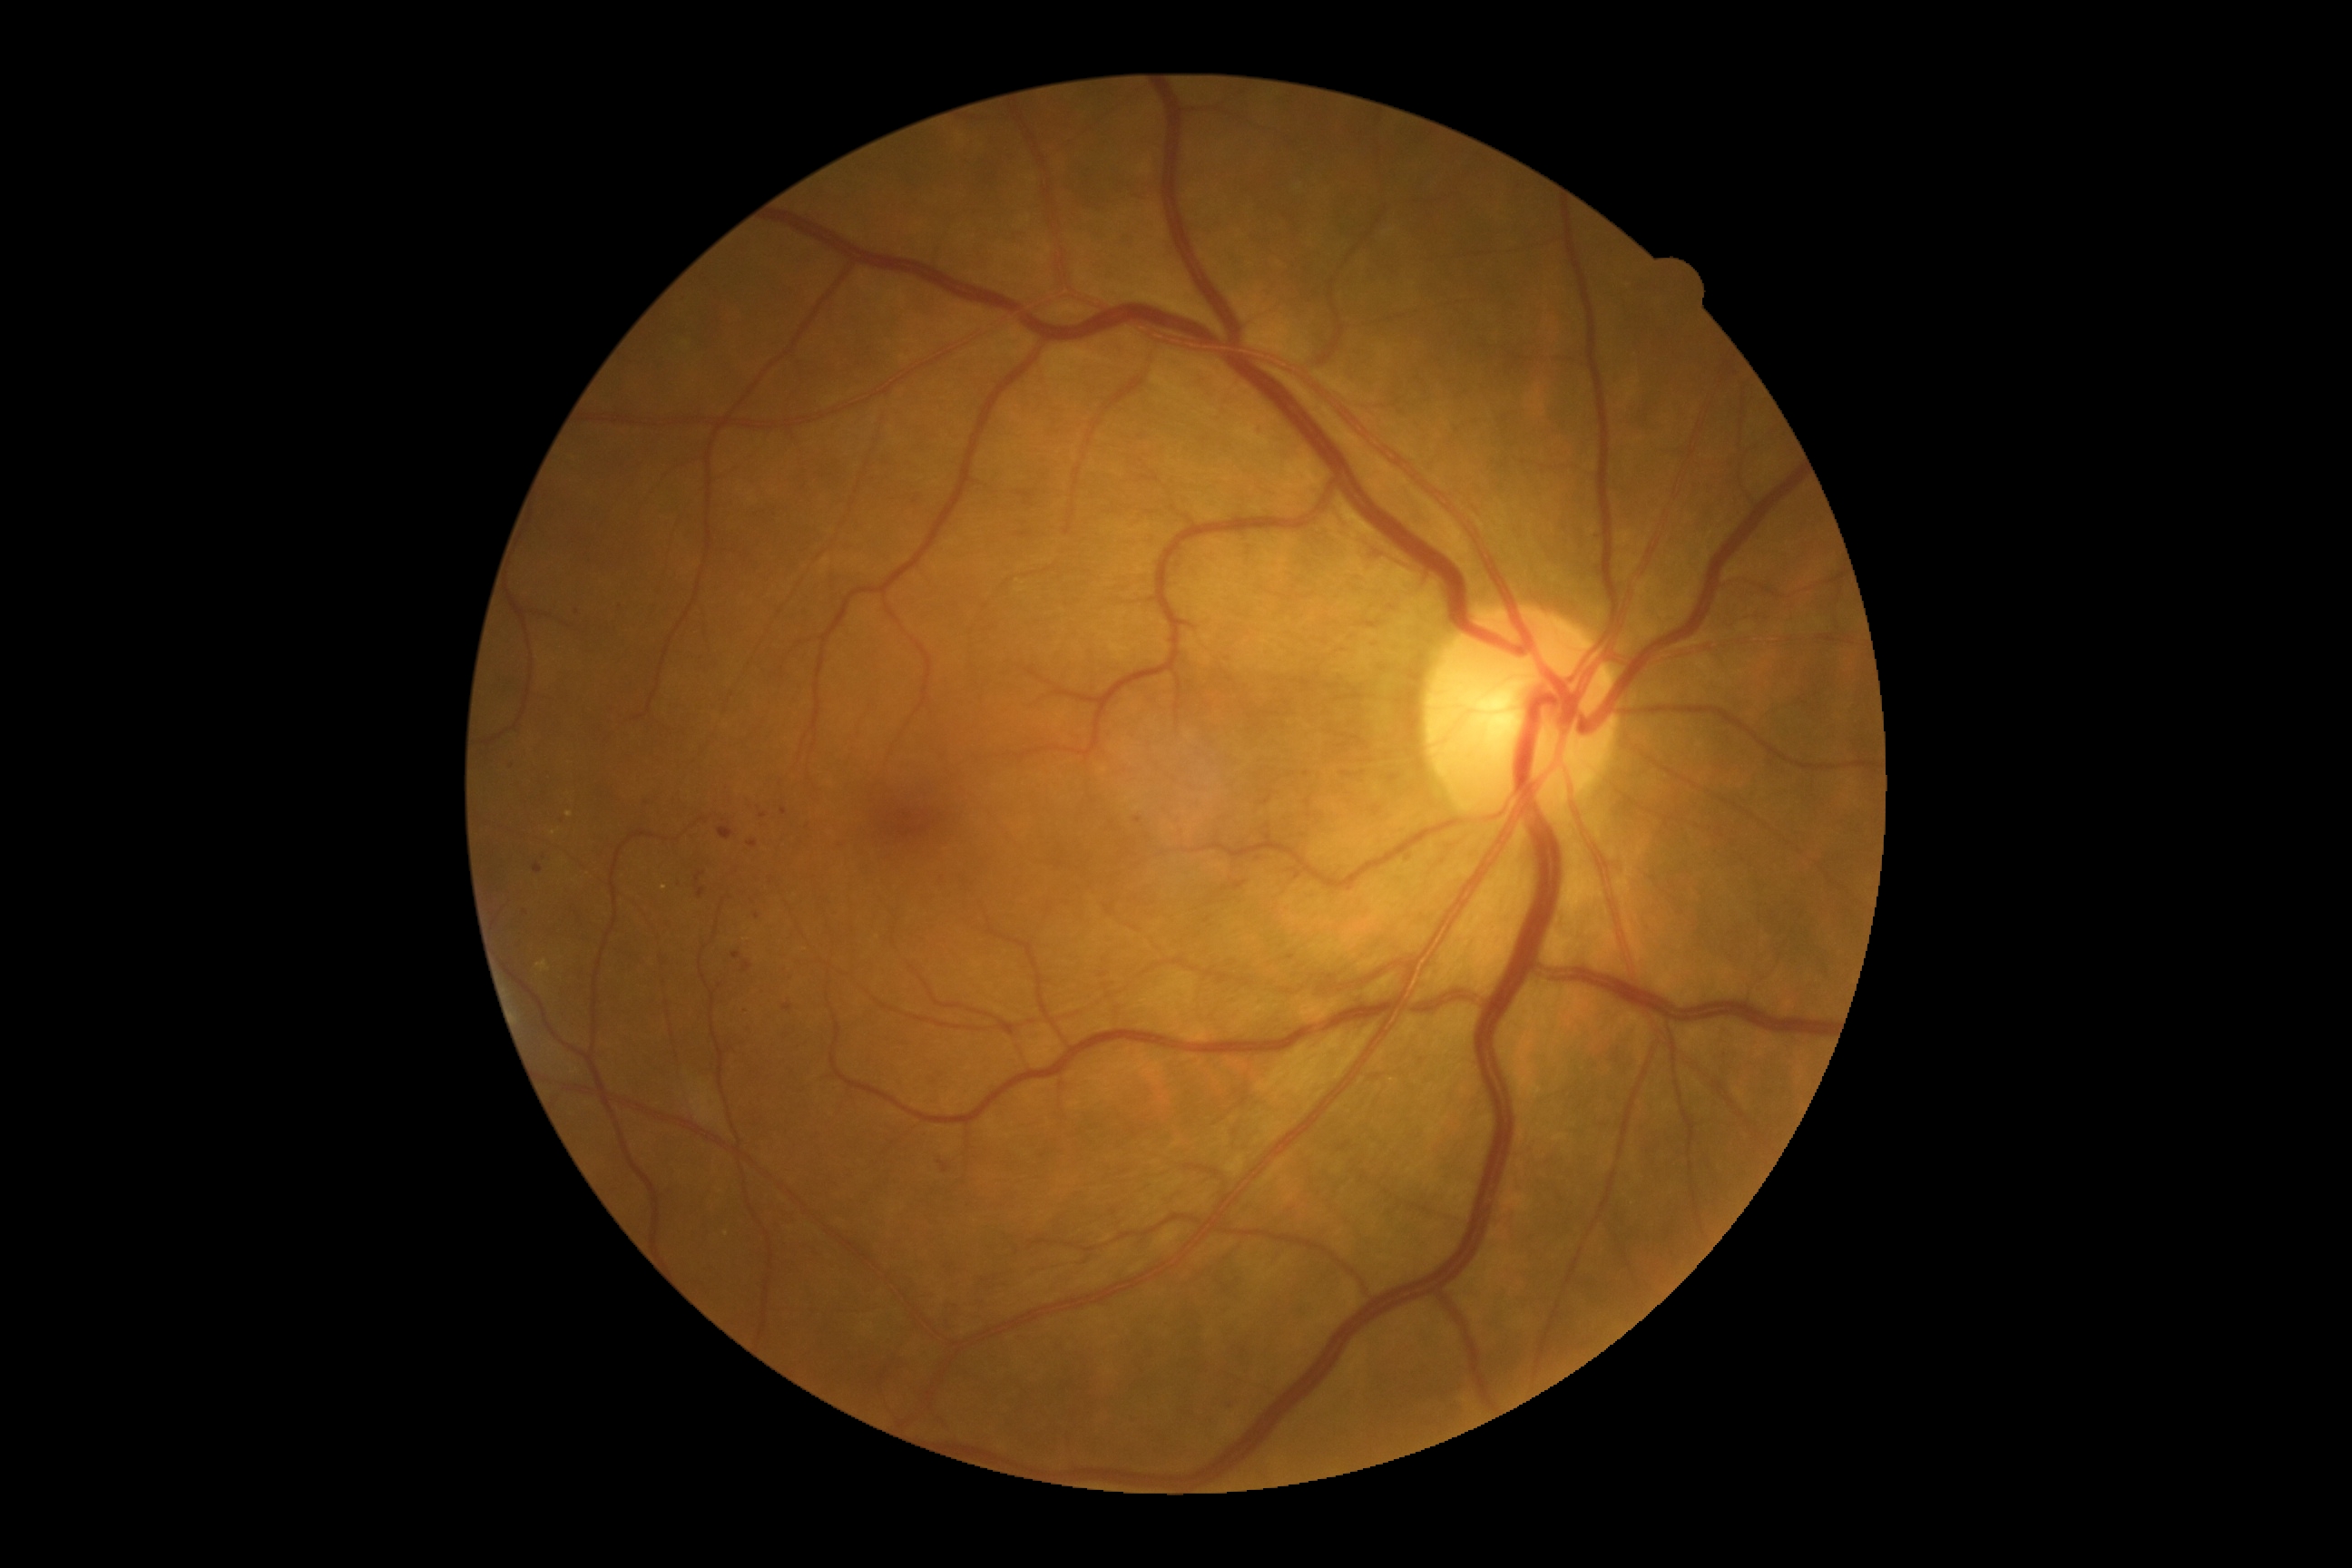
{
  "dr_grade": "2"
}